Retinal fundus photograph:
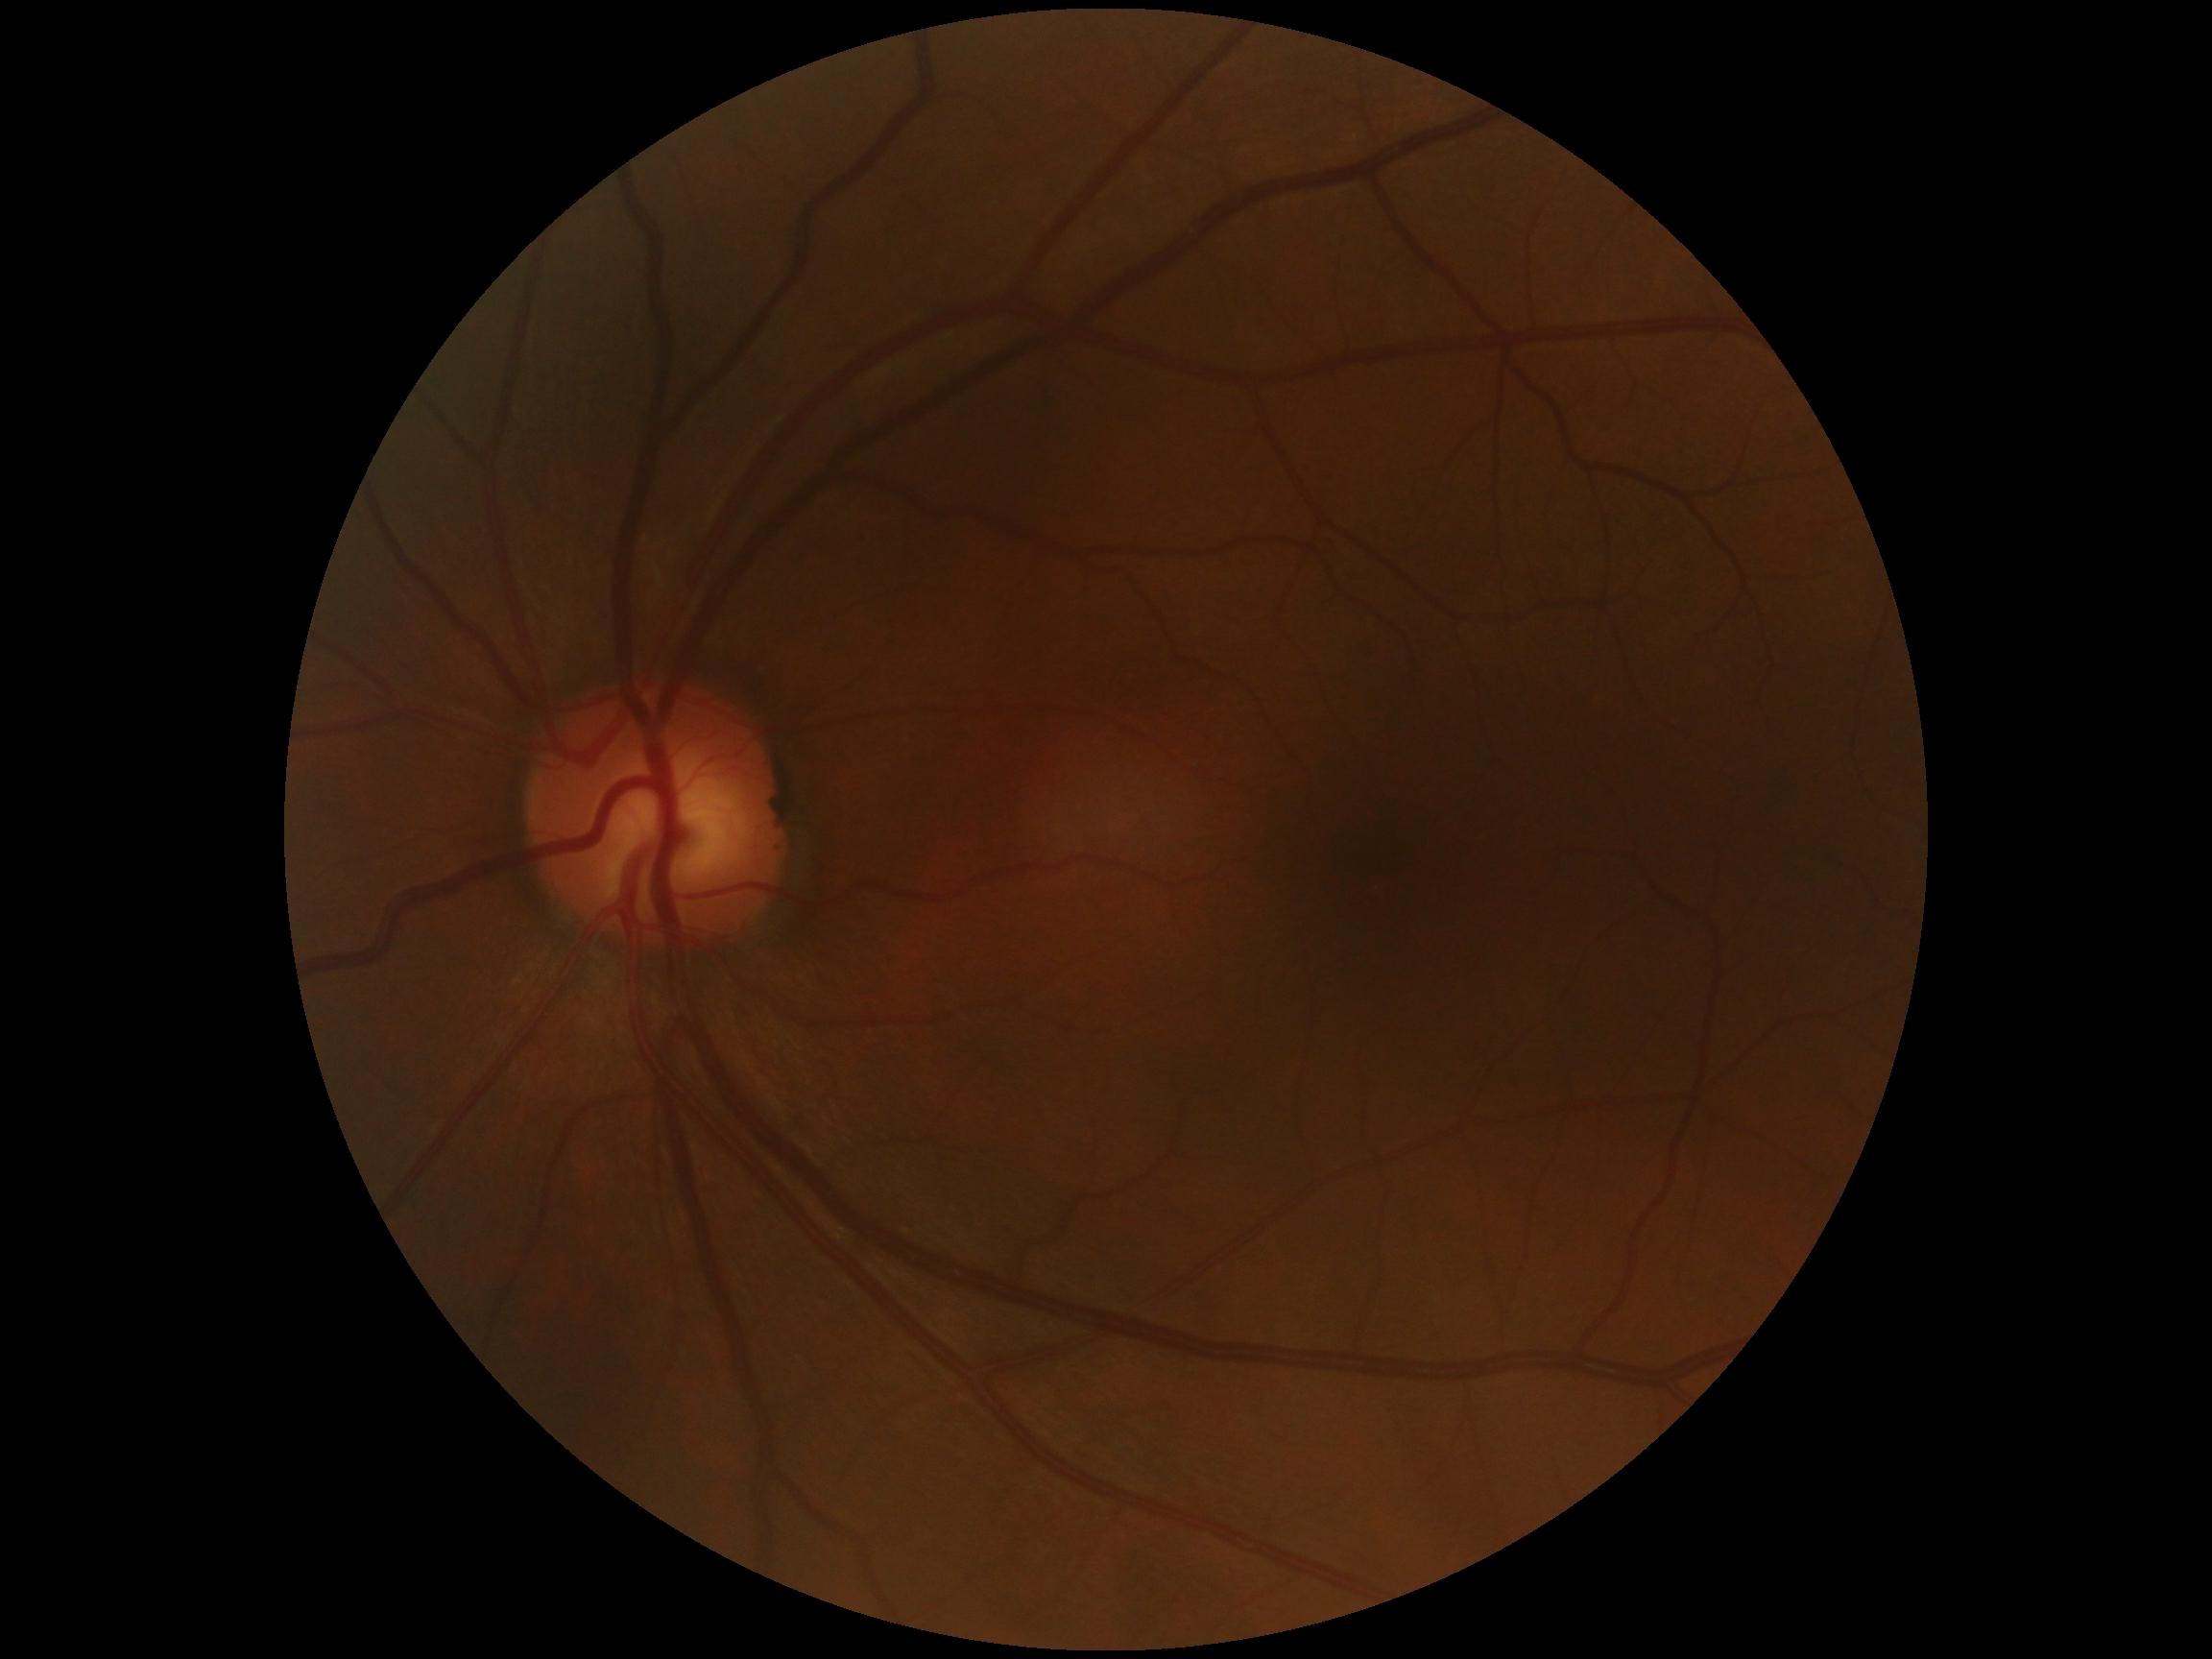
Diabetic retinopathy (DR): grade 0.